NIDEK AFC-230. DR severity per modified Davis staging.
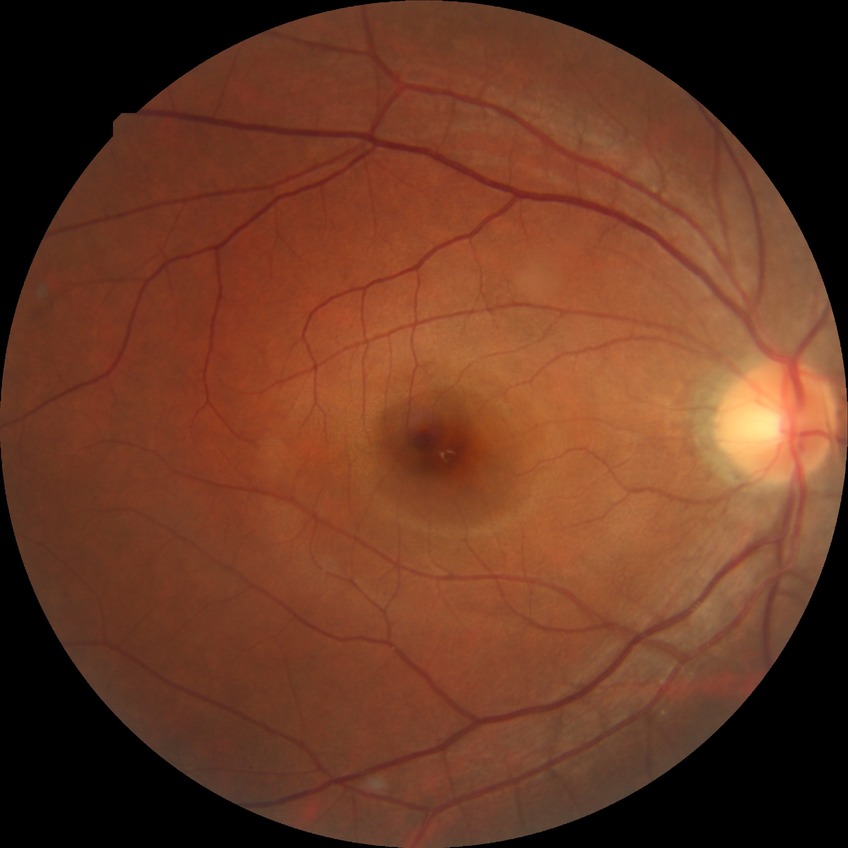

Diabetic retinopathy (DR) is no diabetic retinopathy (NDR).